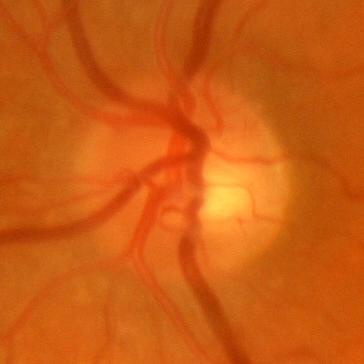 Diagnosis = no glaucomatous changes.